1240x1240px; Phoenix ICON wide-field infant fundus image
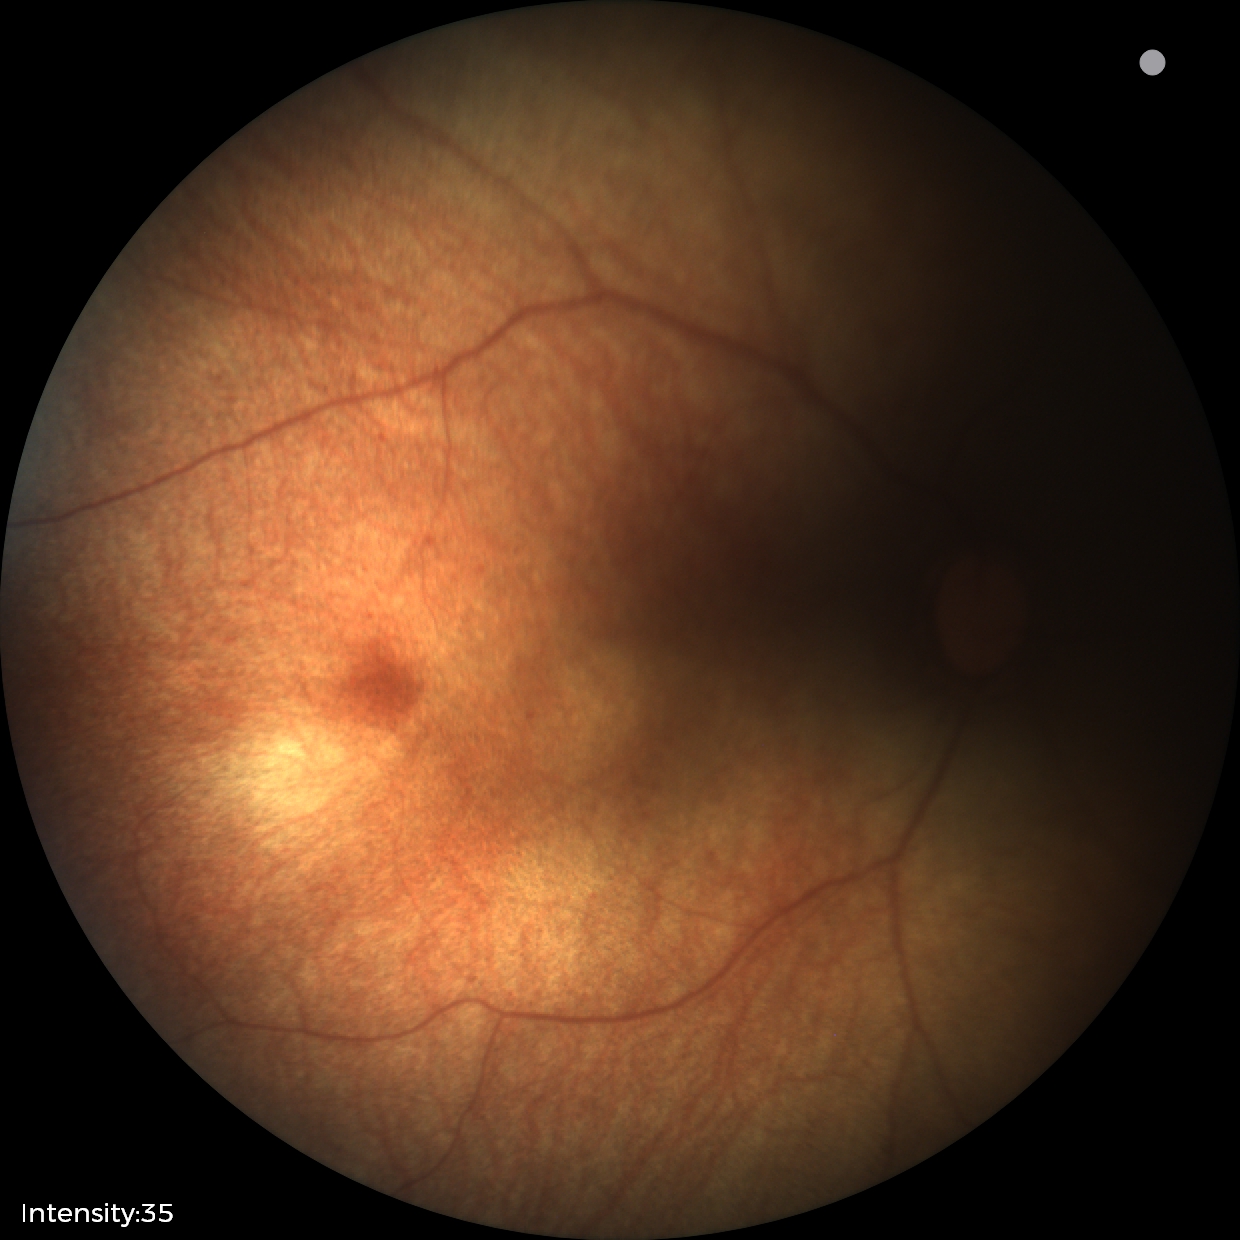
Screening examination diagnosed as physiological.